Color fundus image. 2361x1568px. Camera: Kowa VX-10α. 50° field of view. Pupil-dilated: 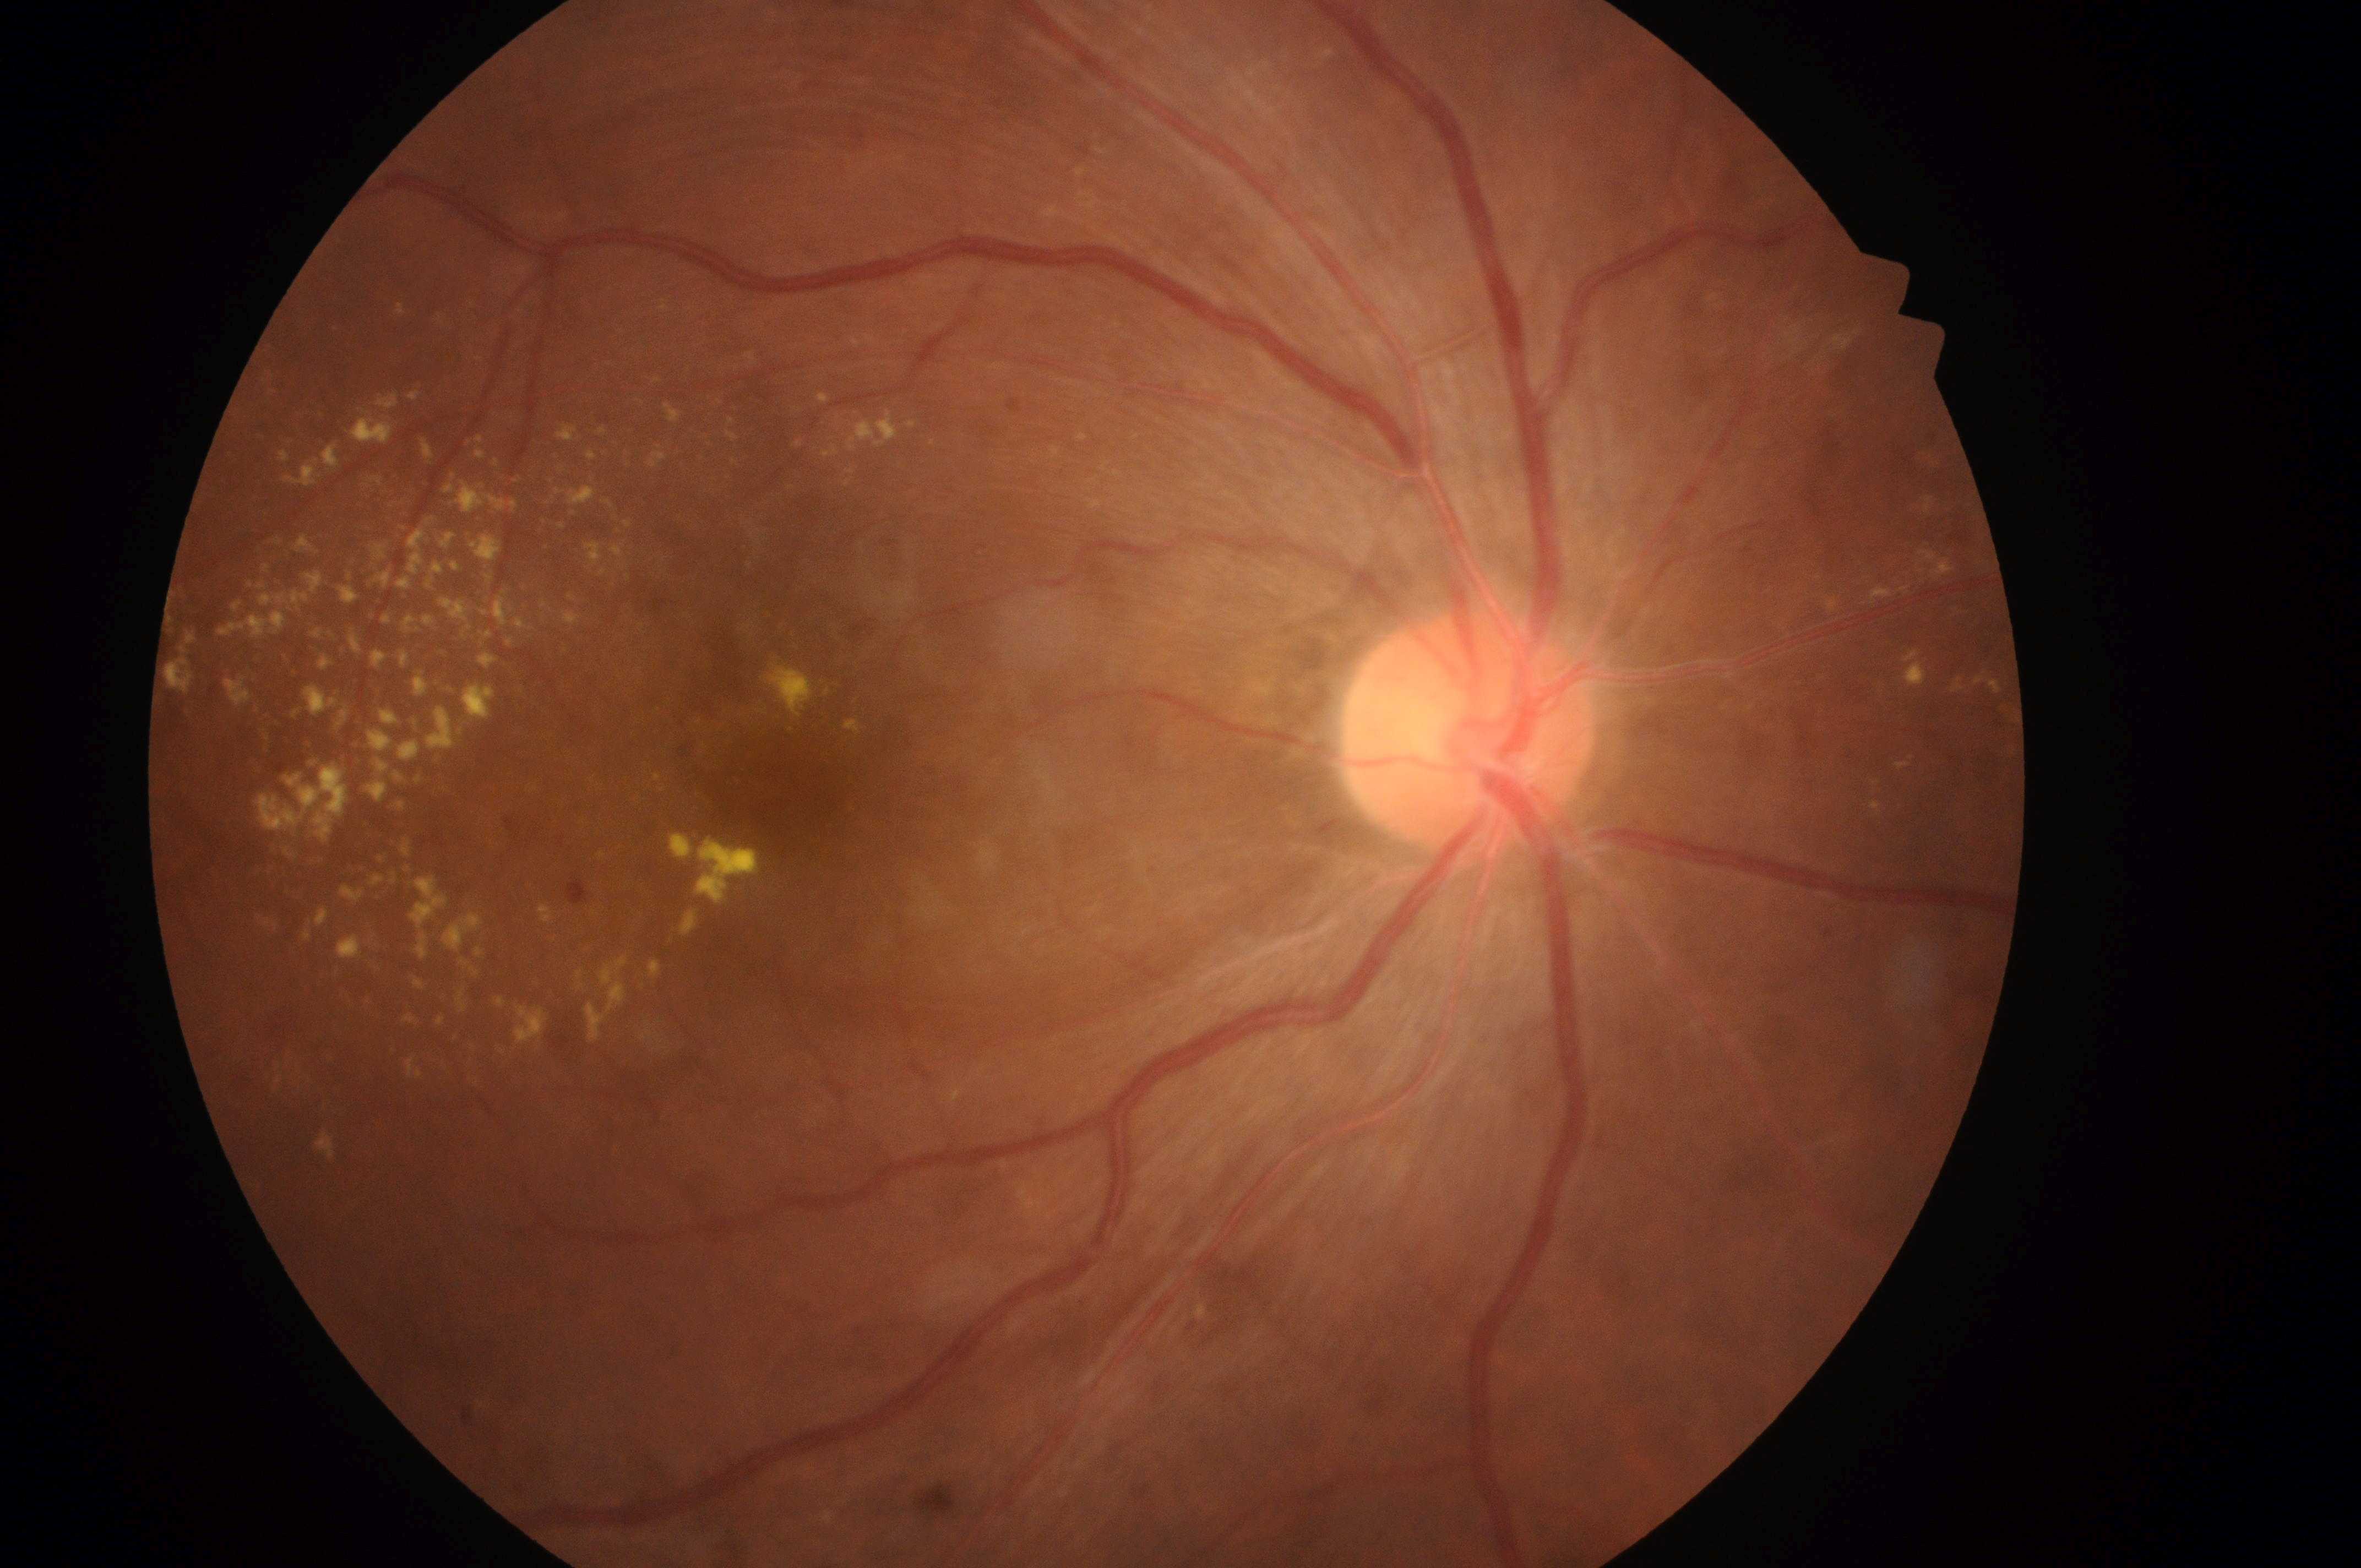

The retinopathy is classified as non-proliferative diabetic retinopathy.
Diabetic macular edema (DME) is grade 2 (high risk).
Fovea: 796px, 793px.
Diabetic retinopathy (DR) is moderate NPDR (grade 2).
Disc center located at 1460px, 736px.
Imaged eye: OD.